No pharmacologic dilation · graded on the modified Davis scale
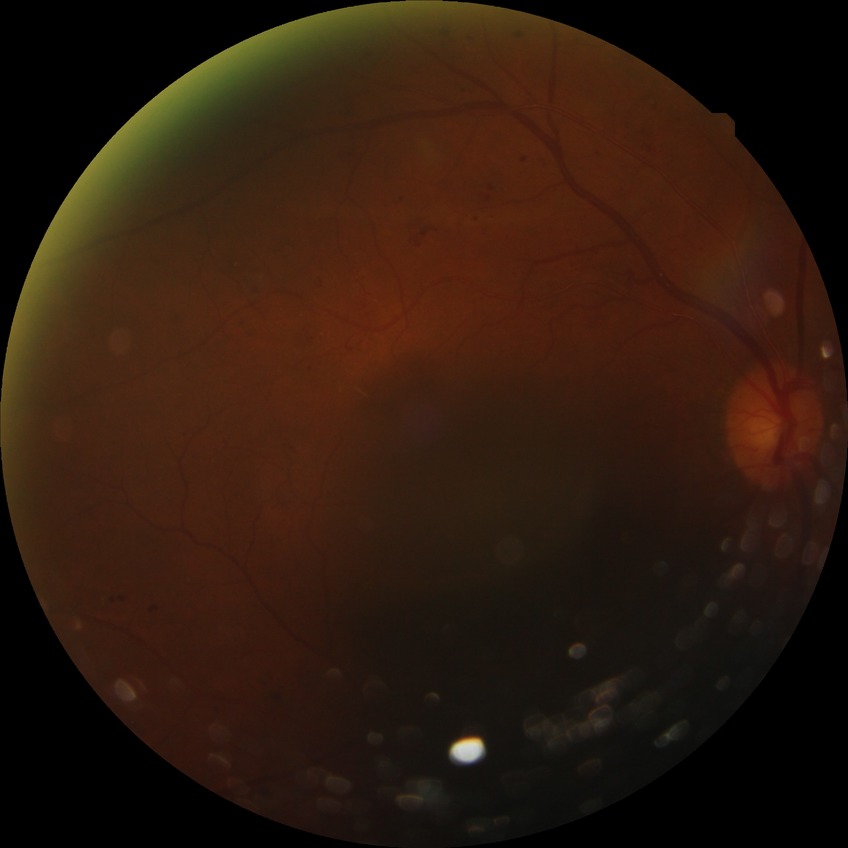 diabetic retinopathy grade = pre-proliferative diabetic retinopathy.